2352 by 1568 pixels. Color fundus photograph.
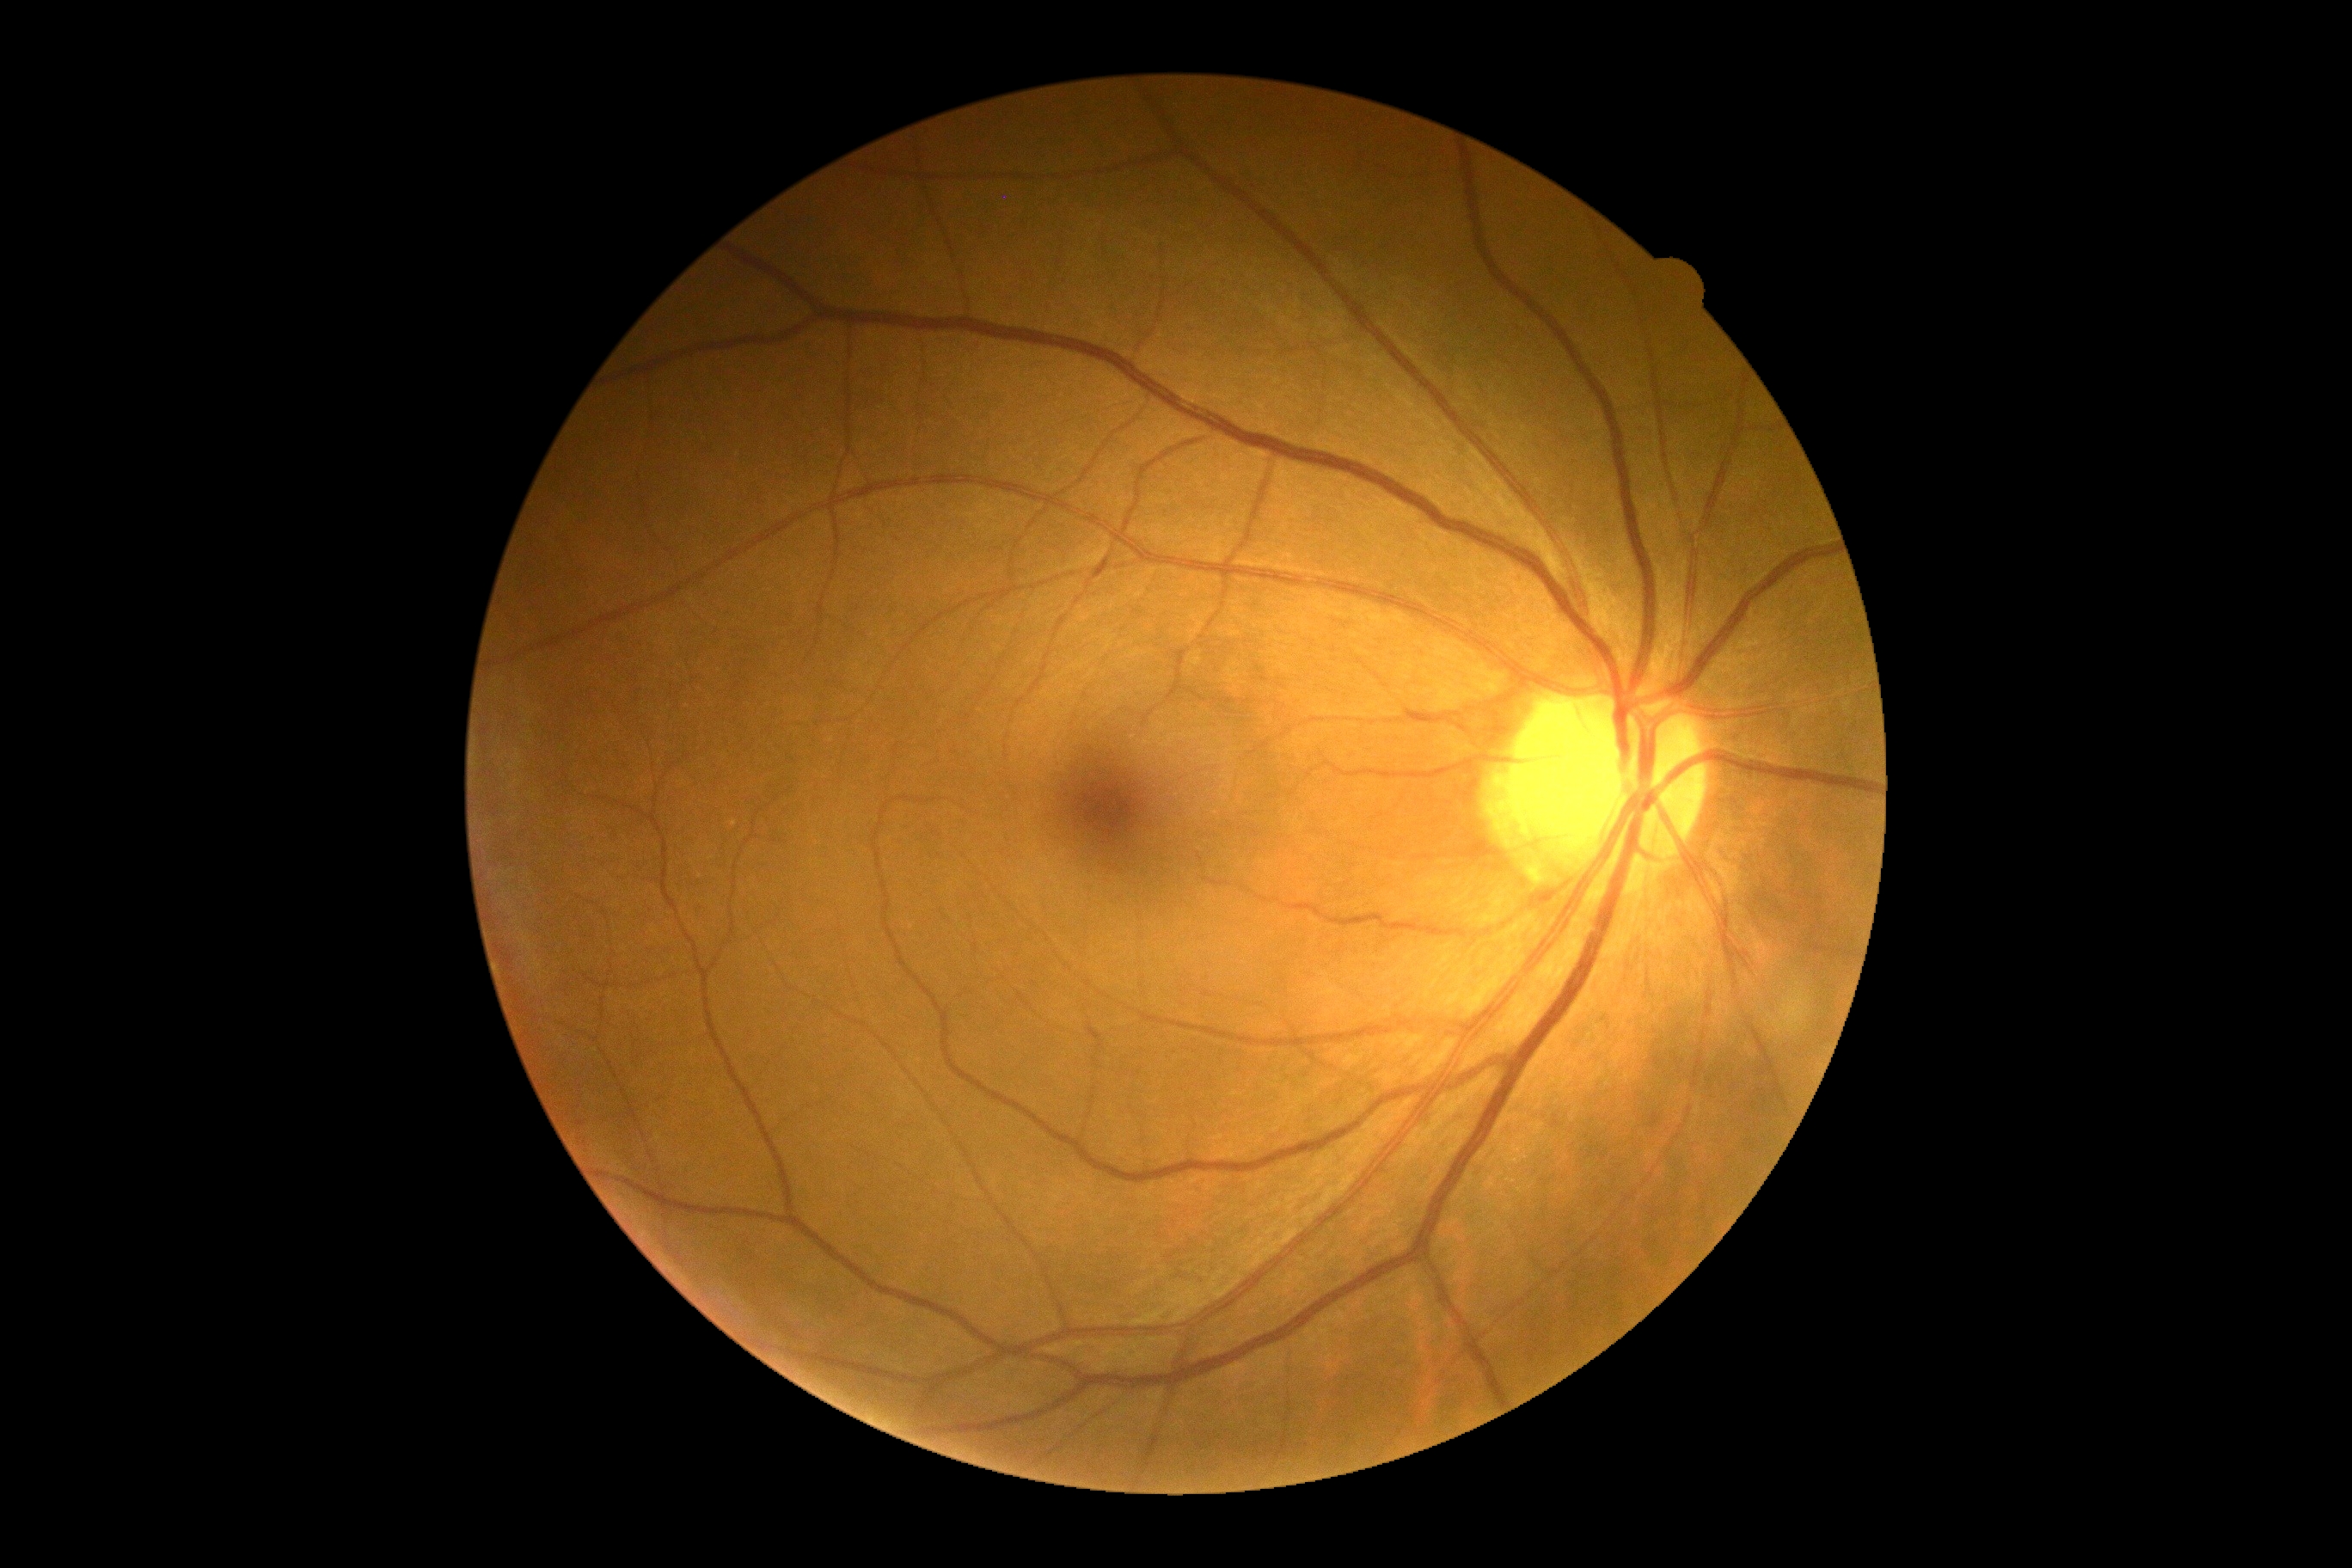
Retinopathy grade: 0 (no apparent retinopathy).